UWF retinal mosaic.
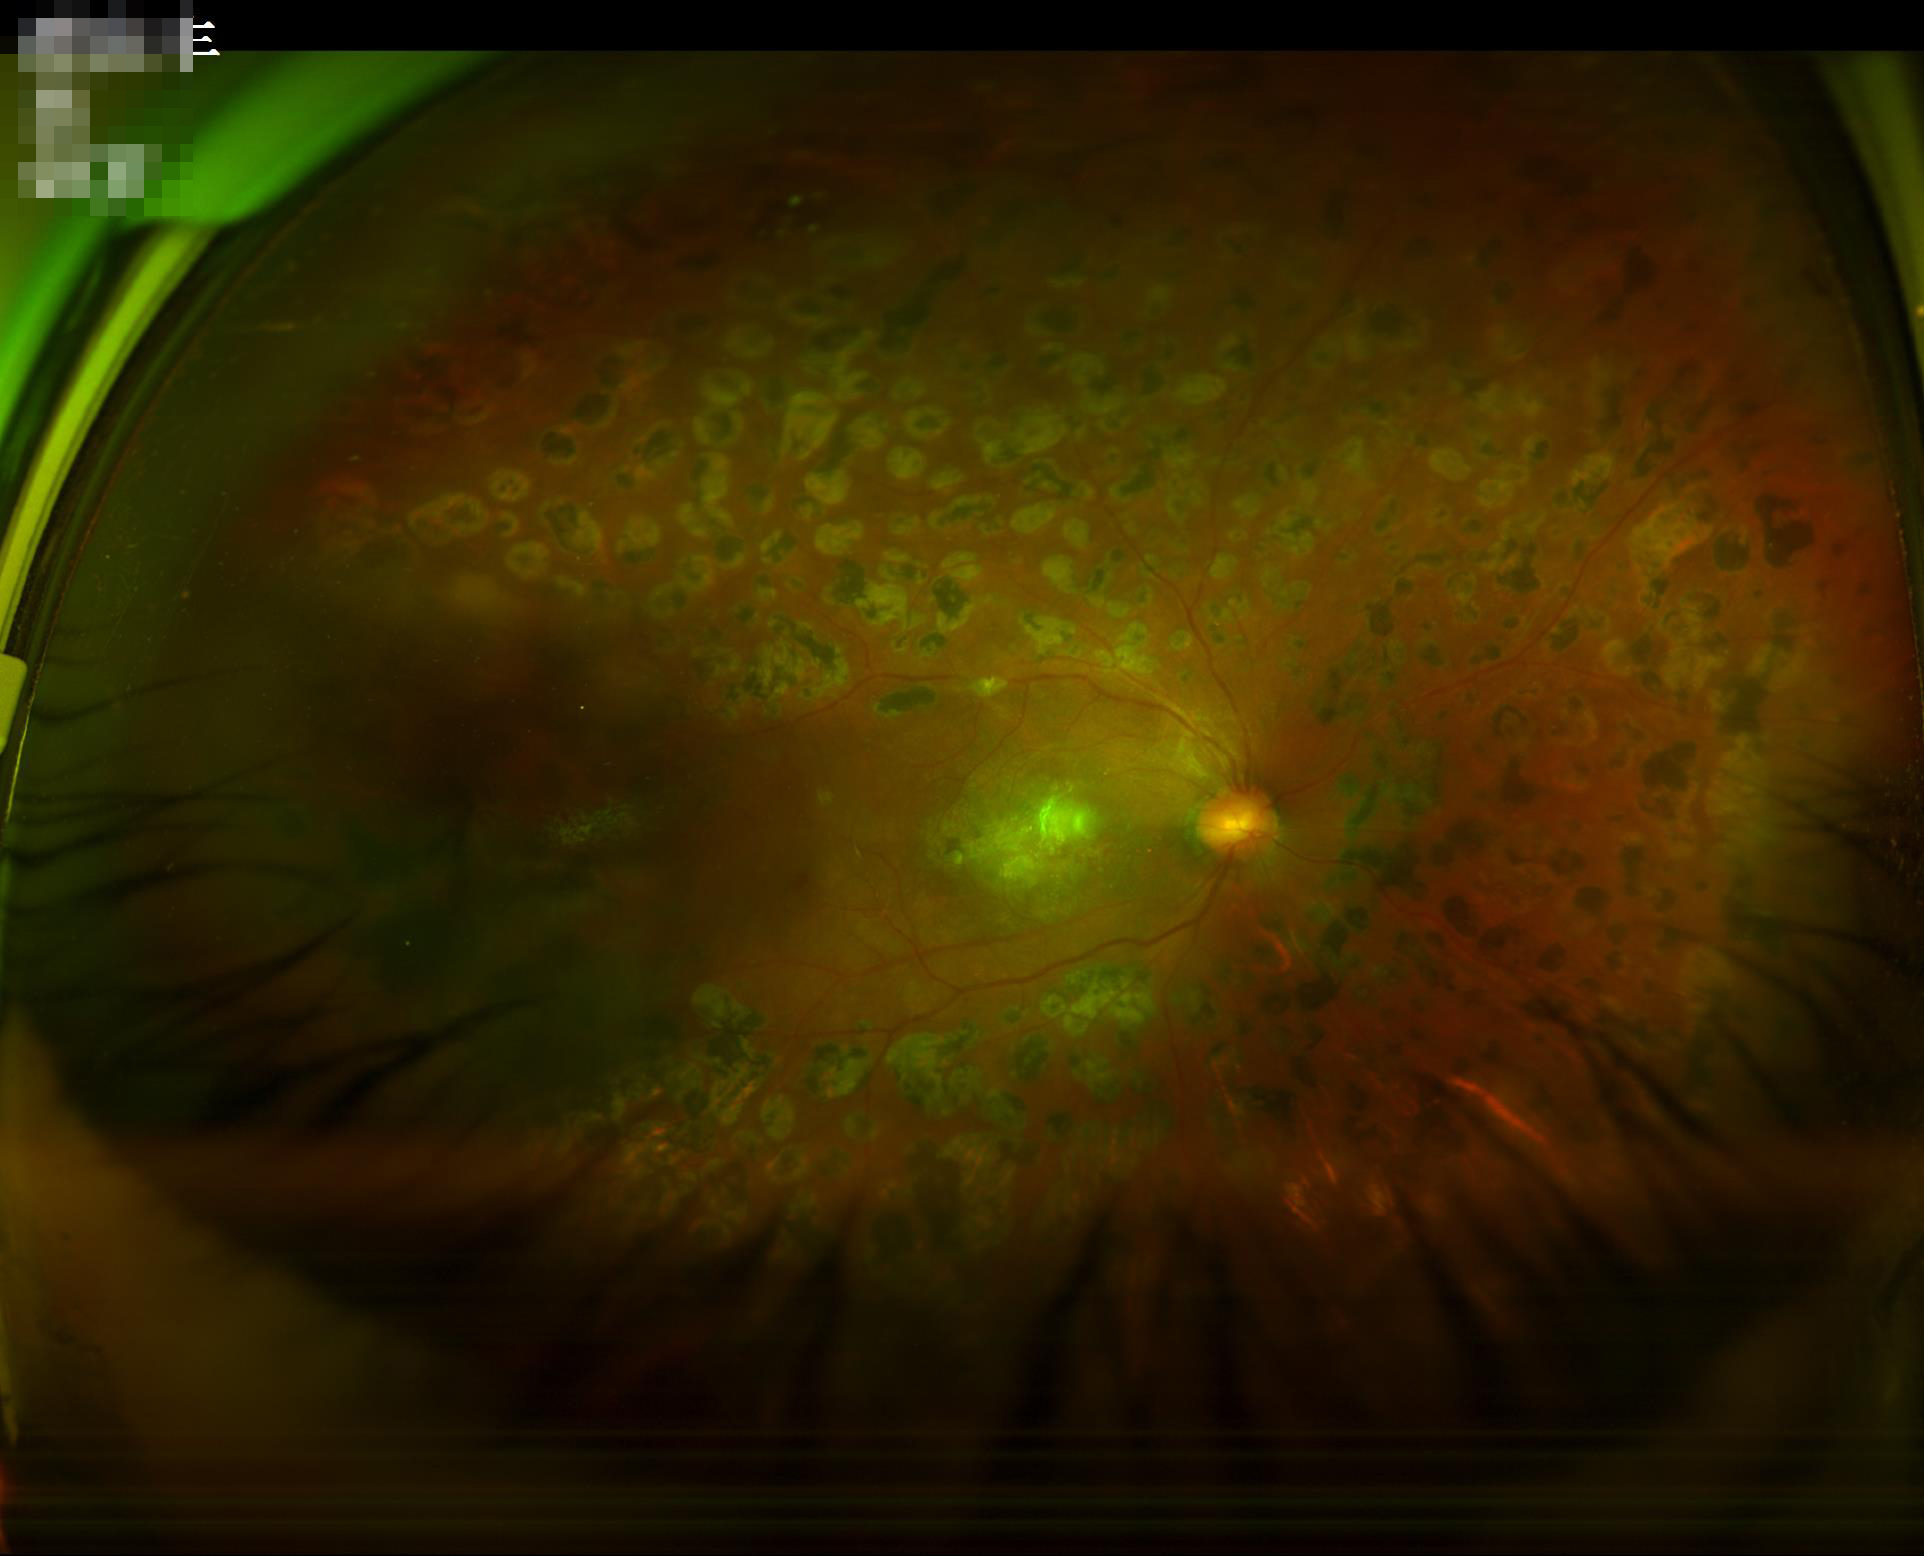
Illumination: inadequate, with uneven exposure or color distortion; Contrast: wide intensity range, structures distinguishable; Sharpness: noticeable blur in the optic disc, vessels, or background; Overall image quality: poor and difficult to use diagnostically.